Pediatric retinal photograph (wide-field) · 1240x1240.
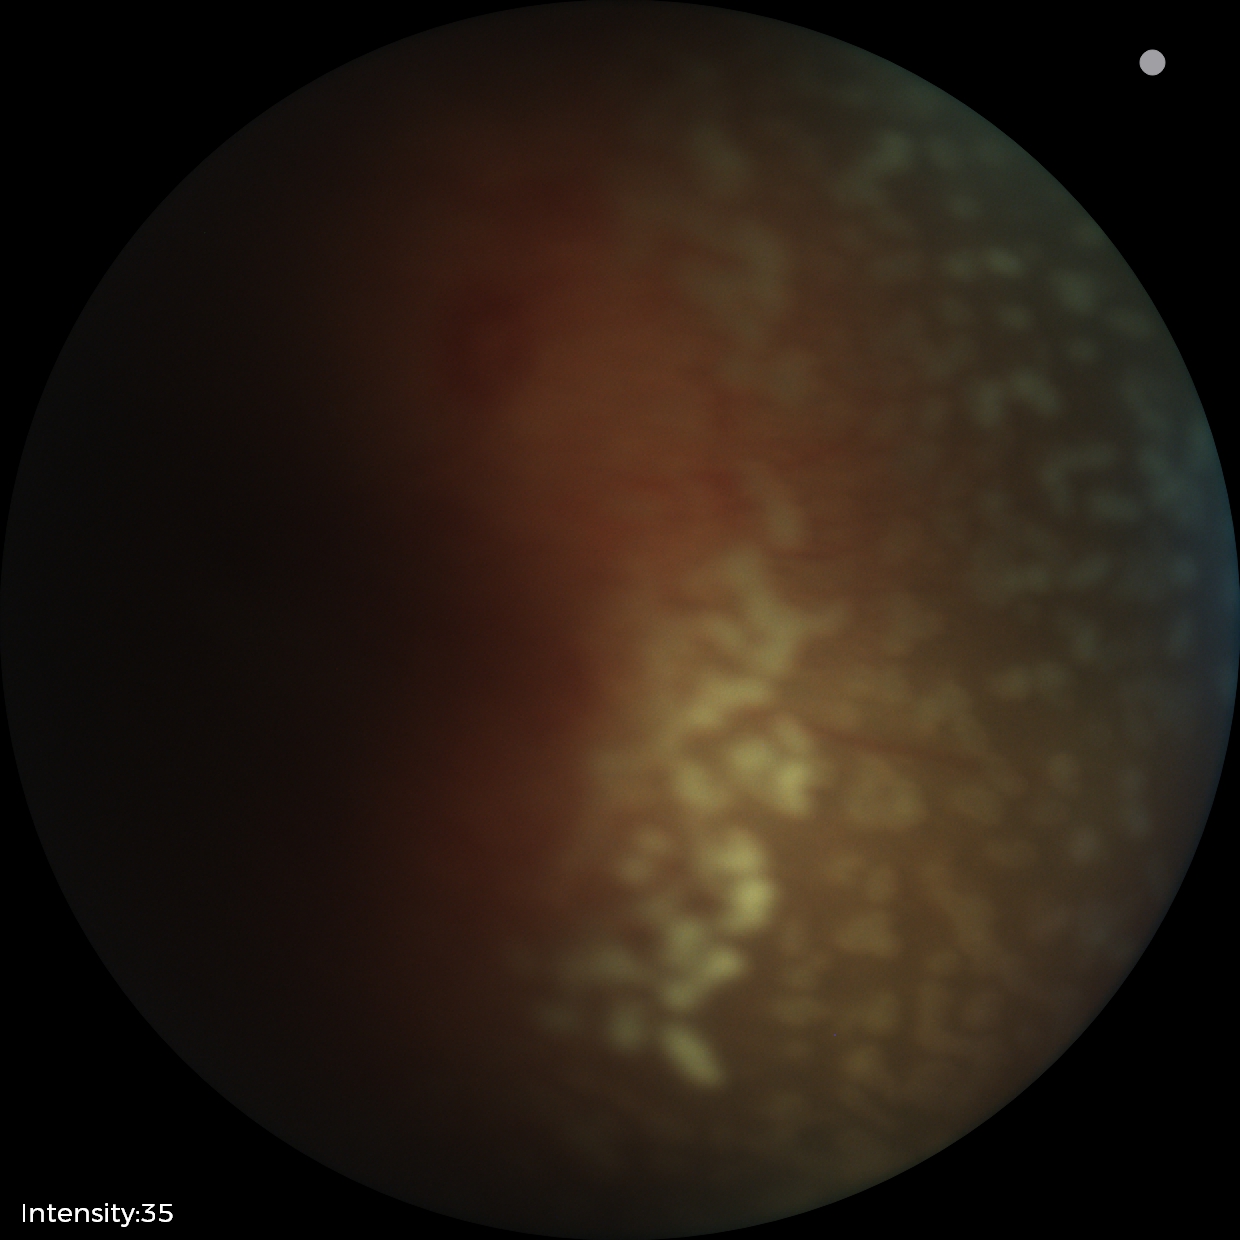 ROP stage: 2 — ridge with height and width at the demarcation line | plus form: present.